Fundus photo · 45-degree field of view.
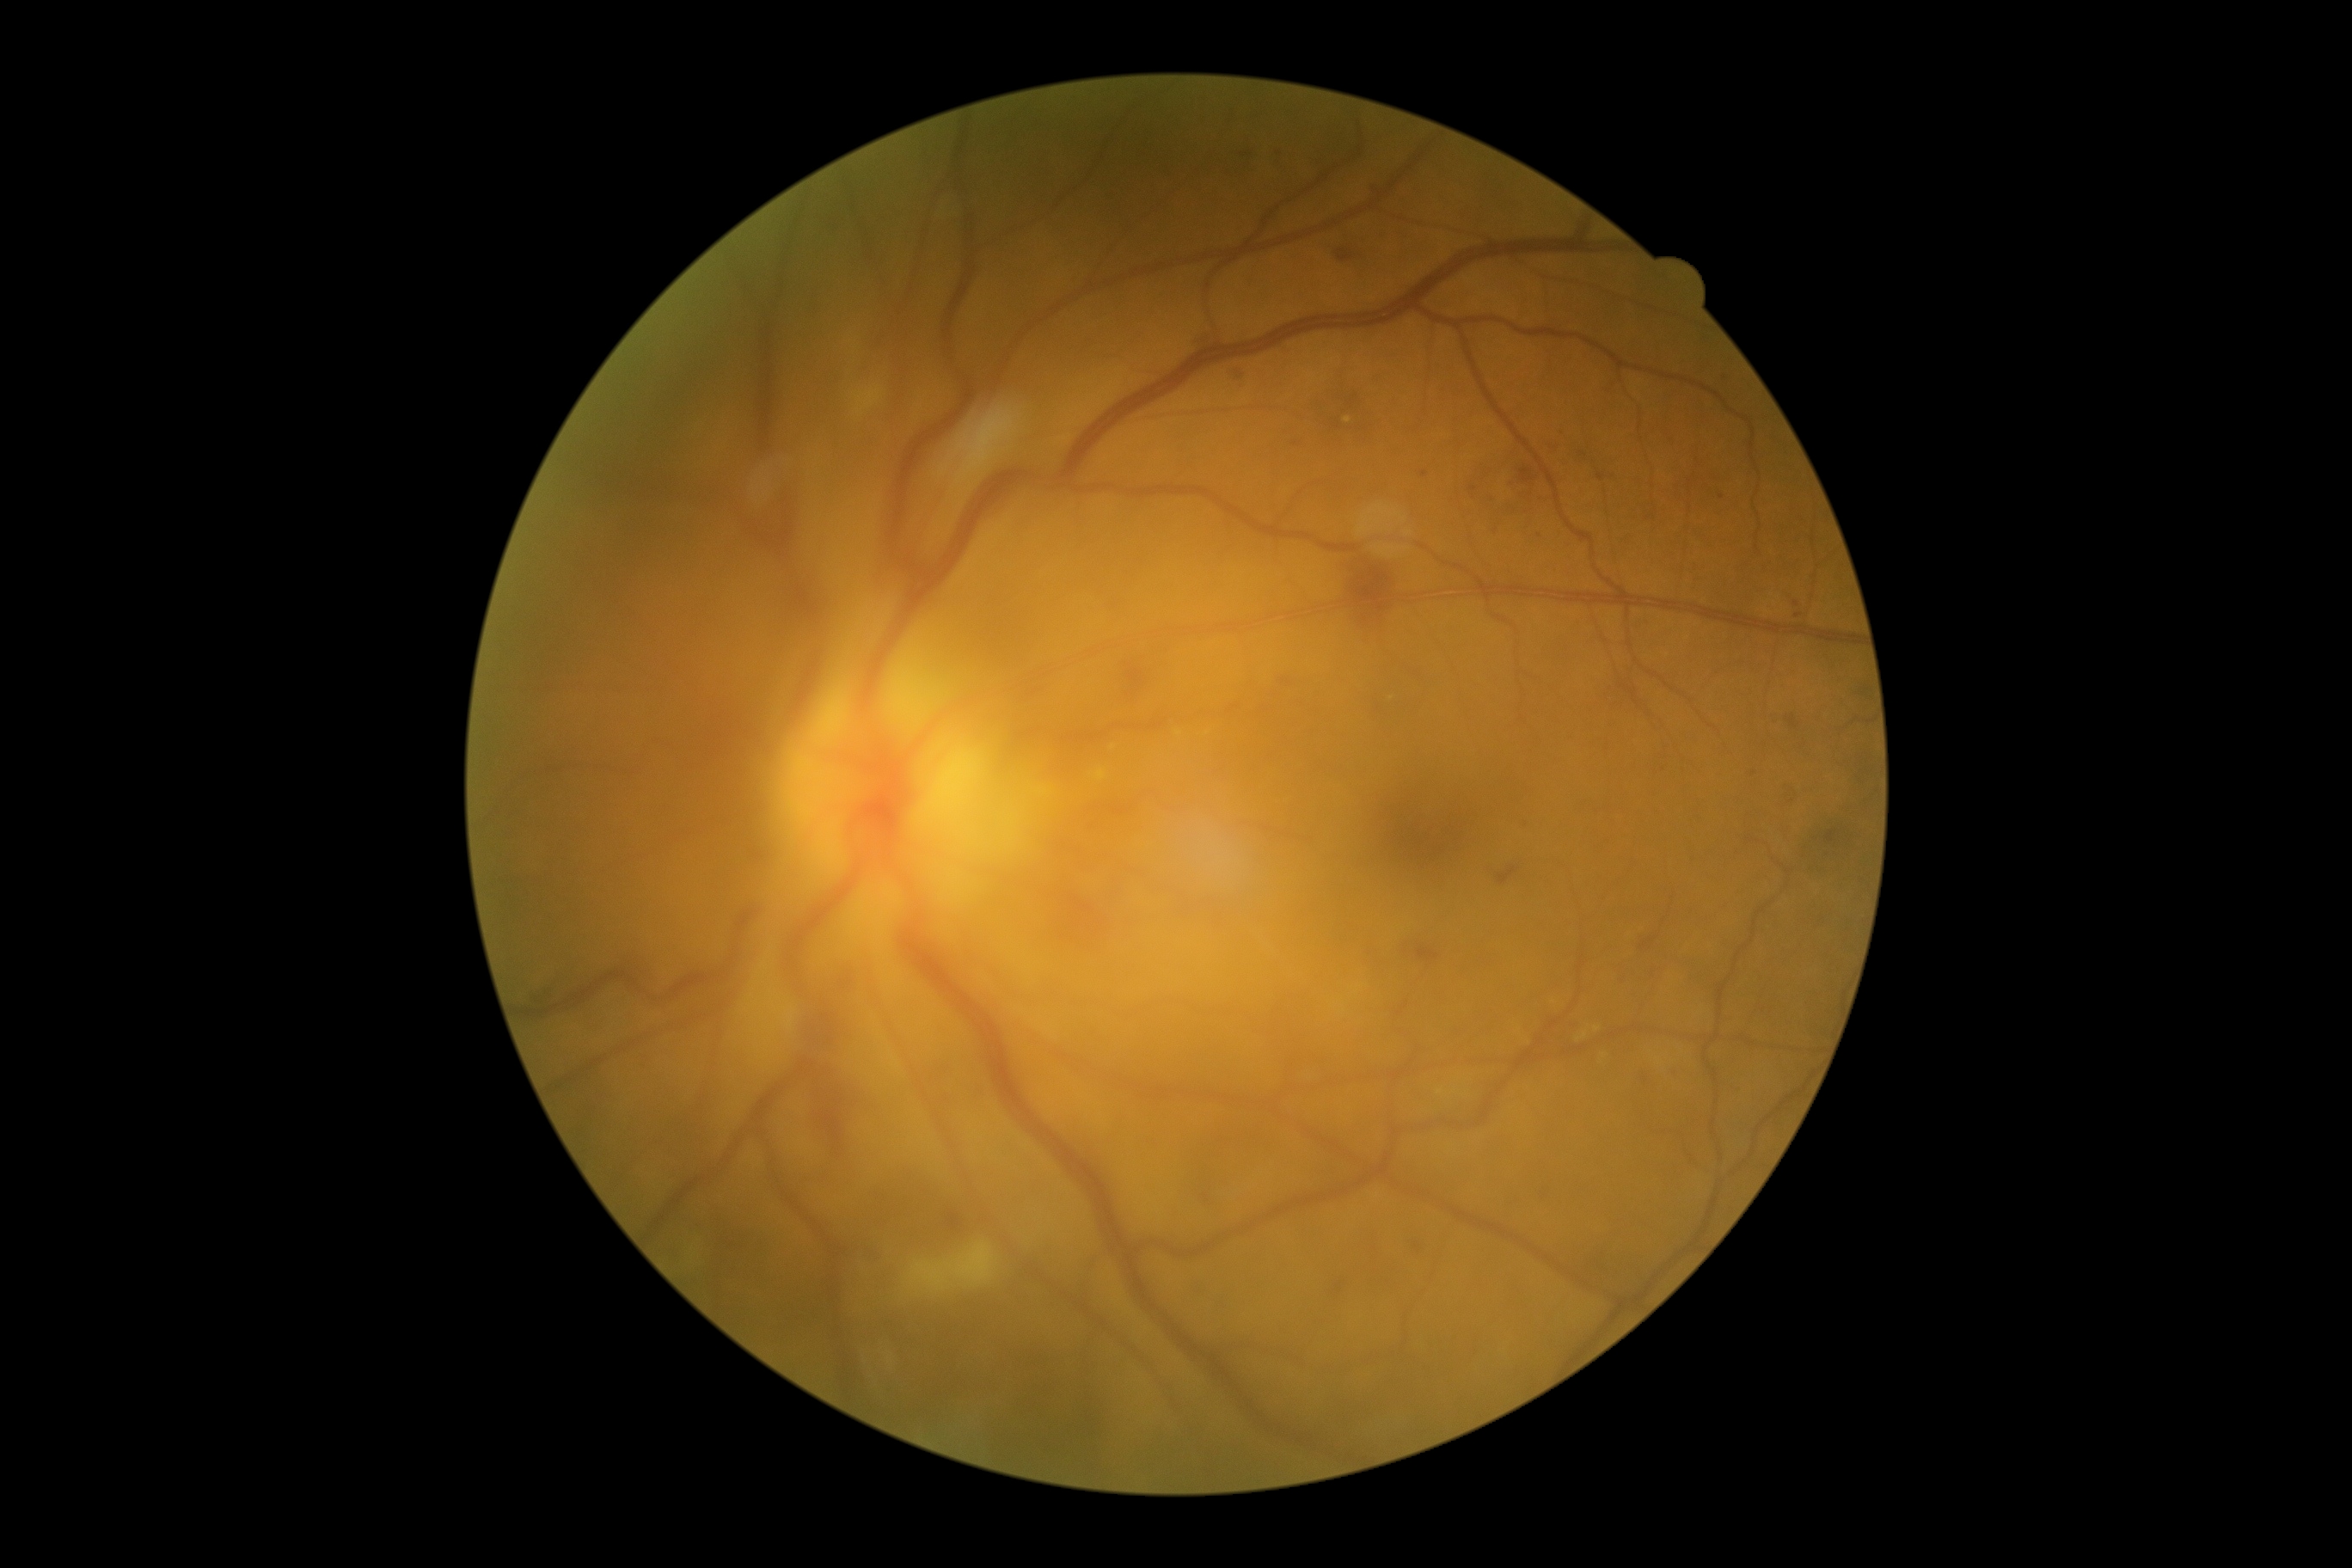   dr_grade: grade 2 (moderate NPDR)